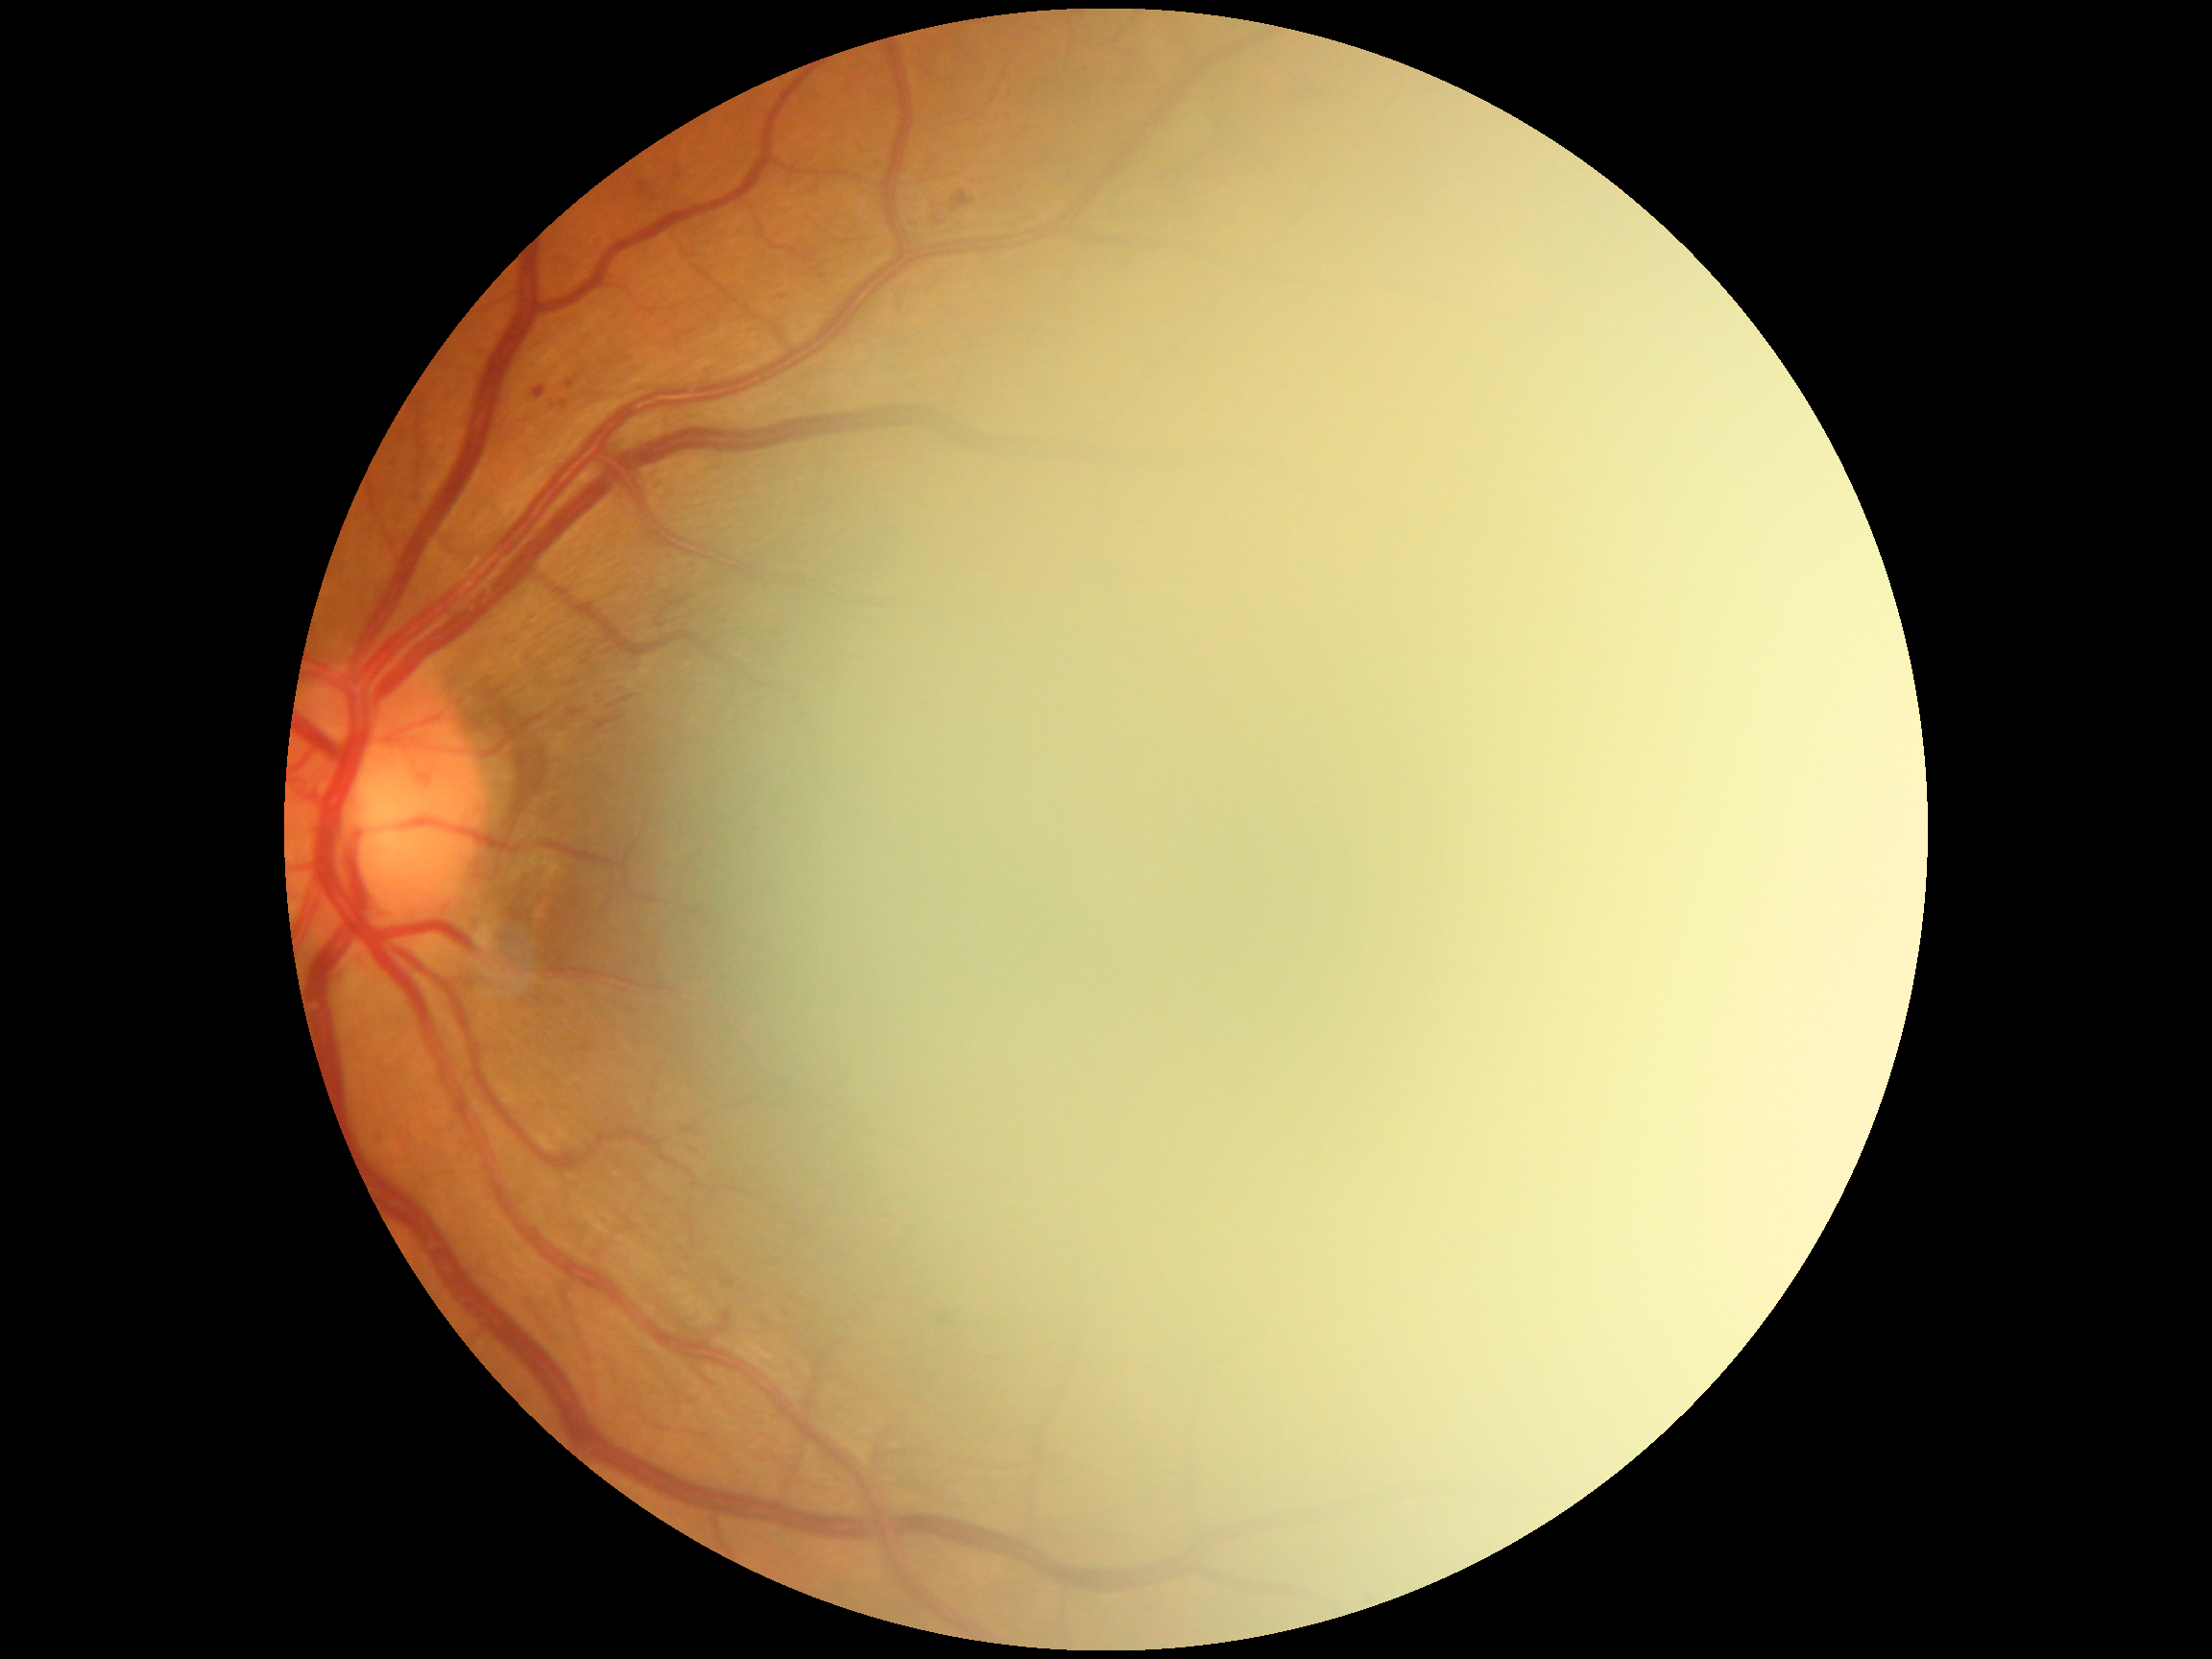
– DR grade — mild non-proliferative diabetic retinopathy (1)